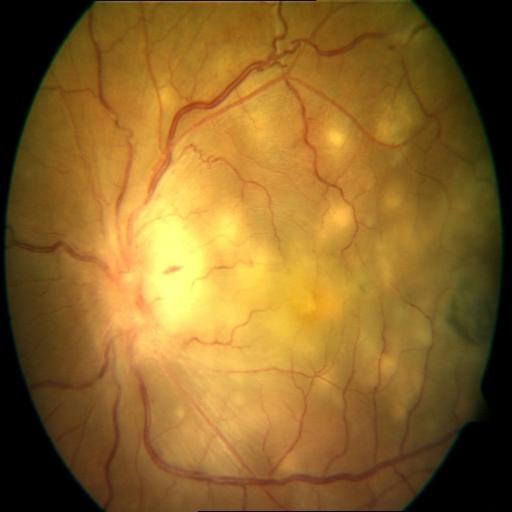

2 abnormalities. Color fundus photograph showing chorioretinitis & optic disc edema.